NIDEK AFC-230 fundus camera · 45 degree fundus photograph · 848 x 848 pixels · posterior pole photograph:
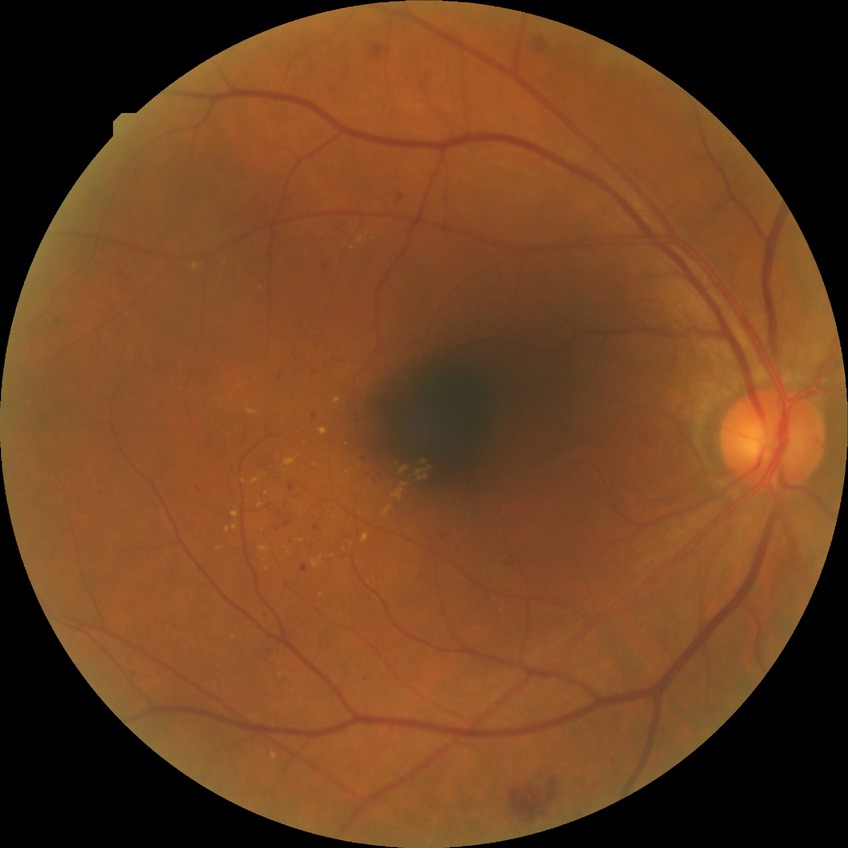

Annotations:
- retinopathy grade — simple diabetic retinopathy